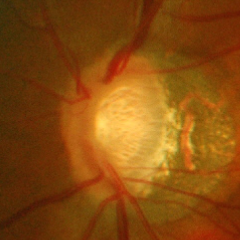
Diagnosis: advanced glaucoma. Defined as near-total cupping of the optic nerve head, with or without severe visual field loss within the central 10 degrees of fixation.